Modified Davis grading, posterior pole color fundus photograph — 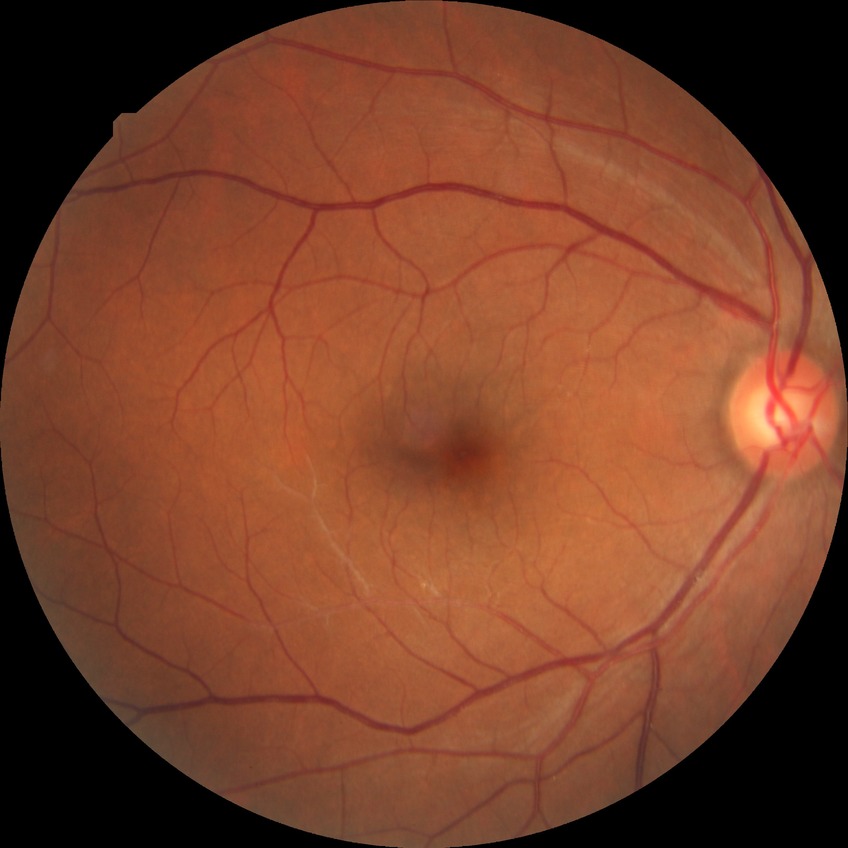 diabetic retinopathy (DR) = no diabetic retinopathy (NDR).